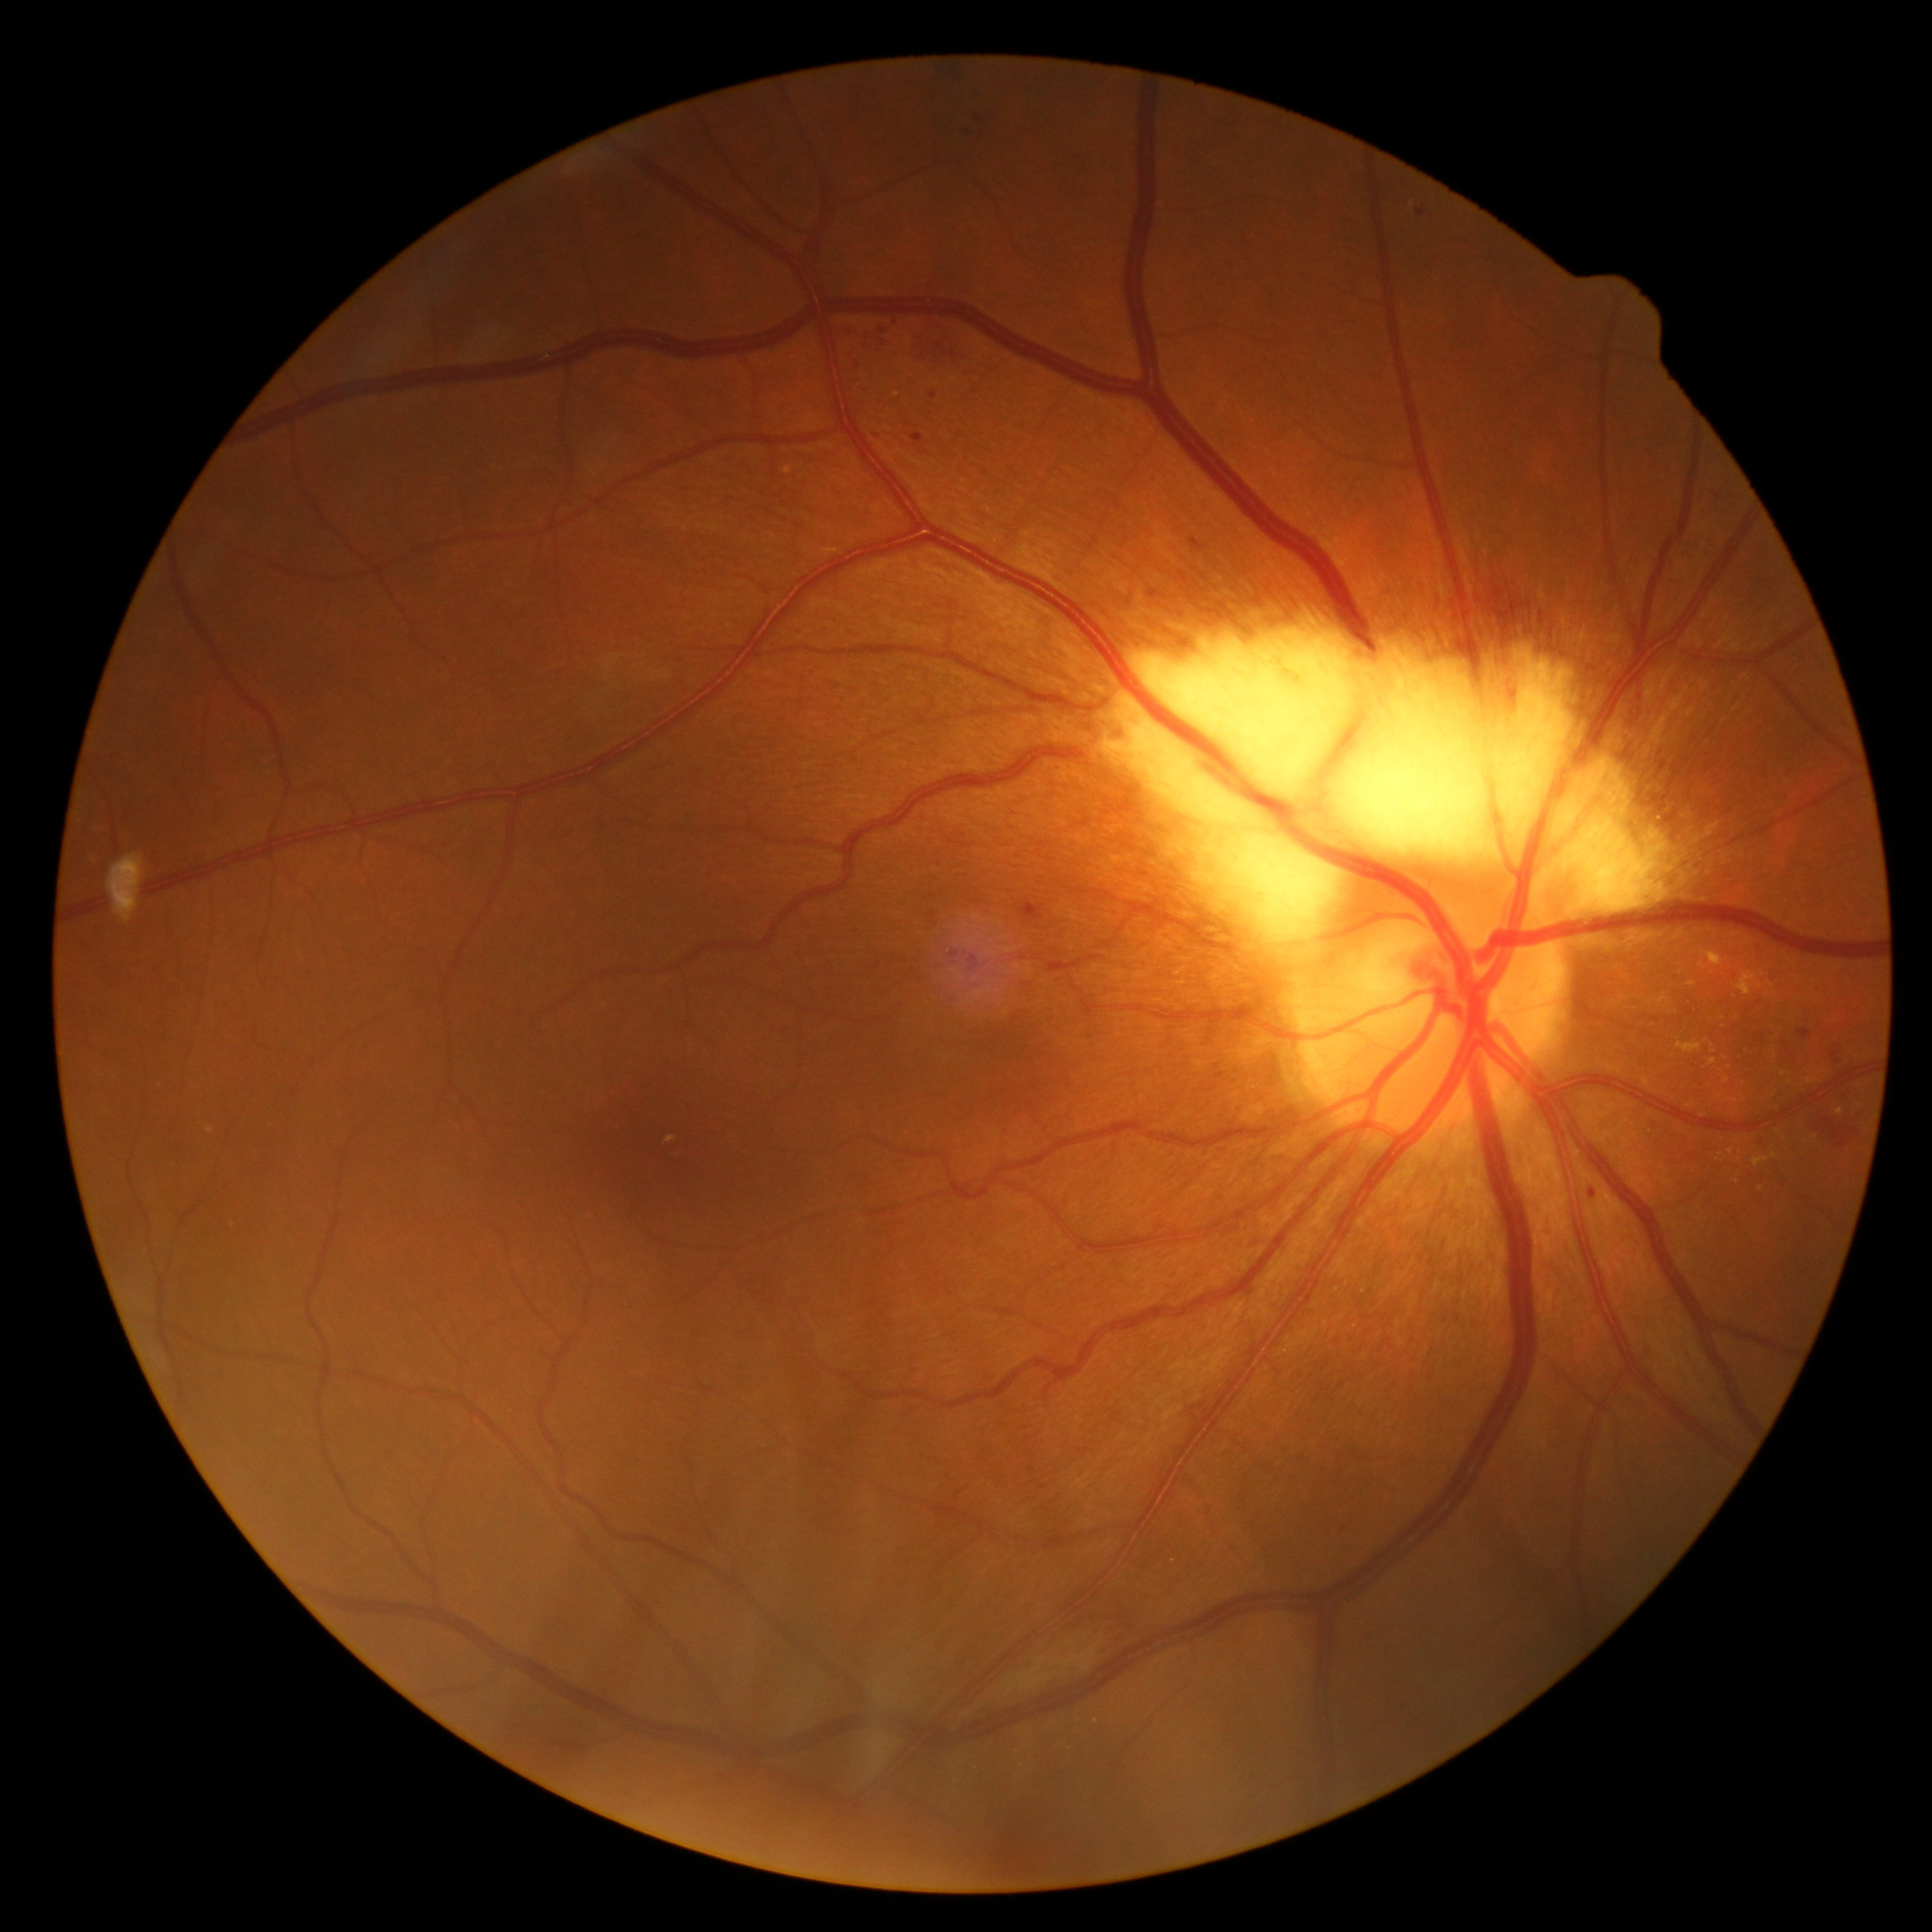

Diabetic retinopathy (DR) is 2
Selected lesions:
hard exudates (EXs) (partial) = box=[1708, 953, 1723, 967]; box=[1688, 981, 1697, 987]; box=[1646, 992, 1677, 1014]; box=[1709, 1058, 1717, 1066]
Smaller EXs around x=1790, y=1083; x=1704, y=1116; x=1775, y=1157; x=1725, y=1058; x=1732, y=1152; x=1840, y=1112